Mydriatic · 853 by 853 pixels · optic disc-centered crop from a color fundus photograph:
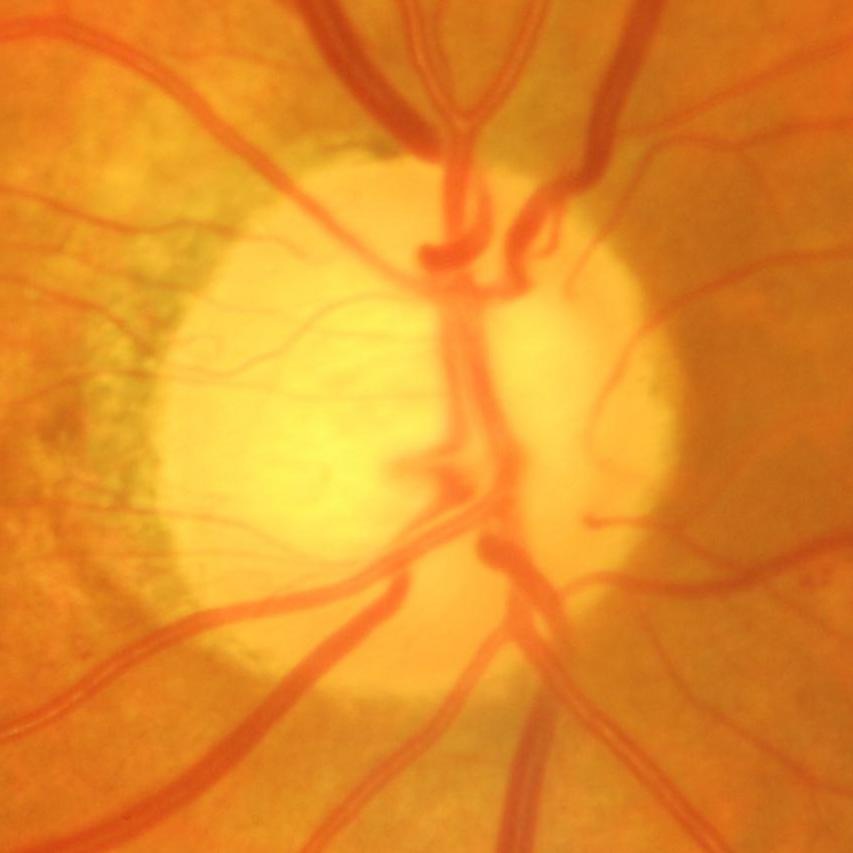

Consistent with evidence of glaucoma.